30° field of view:
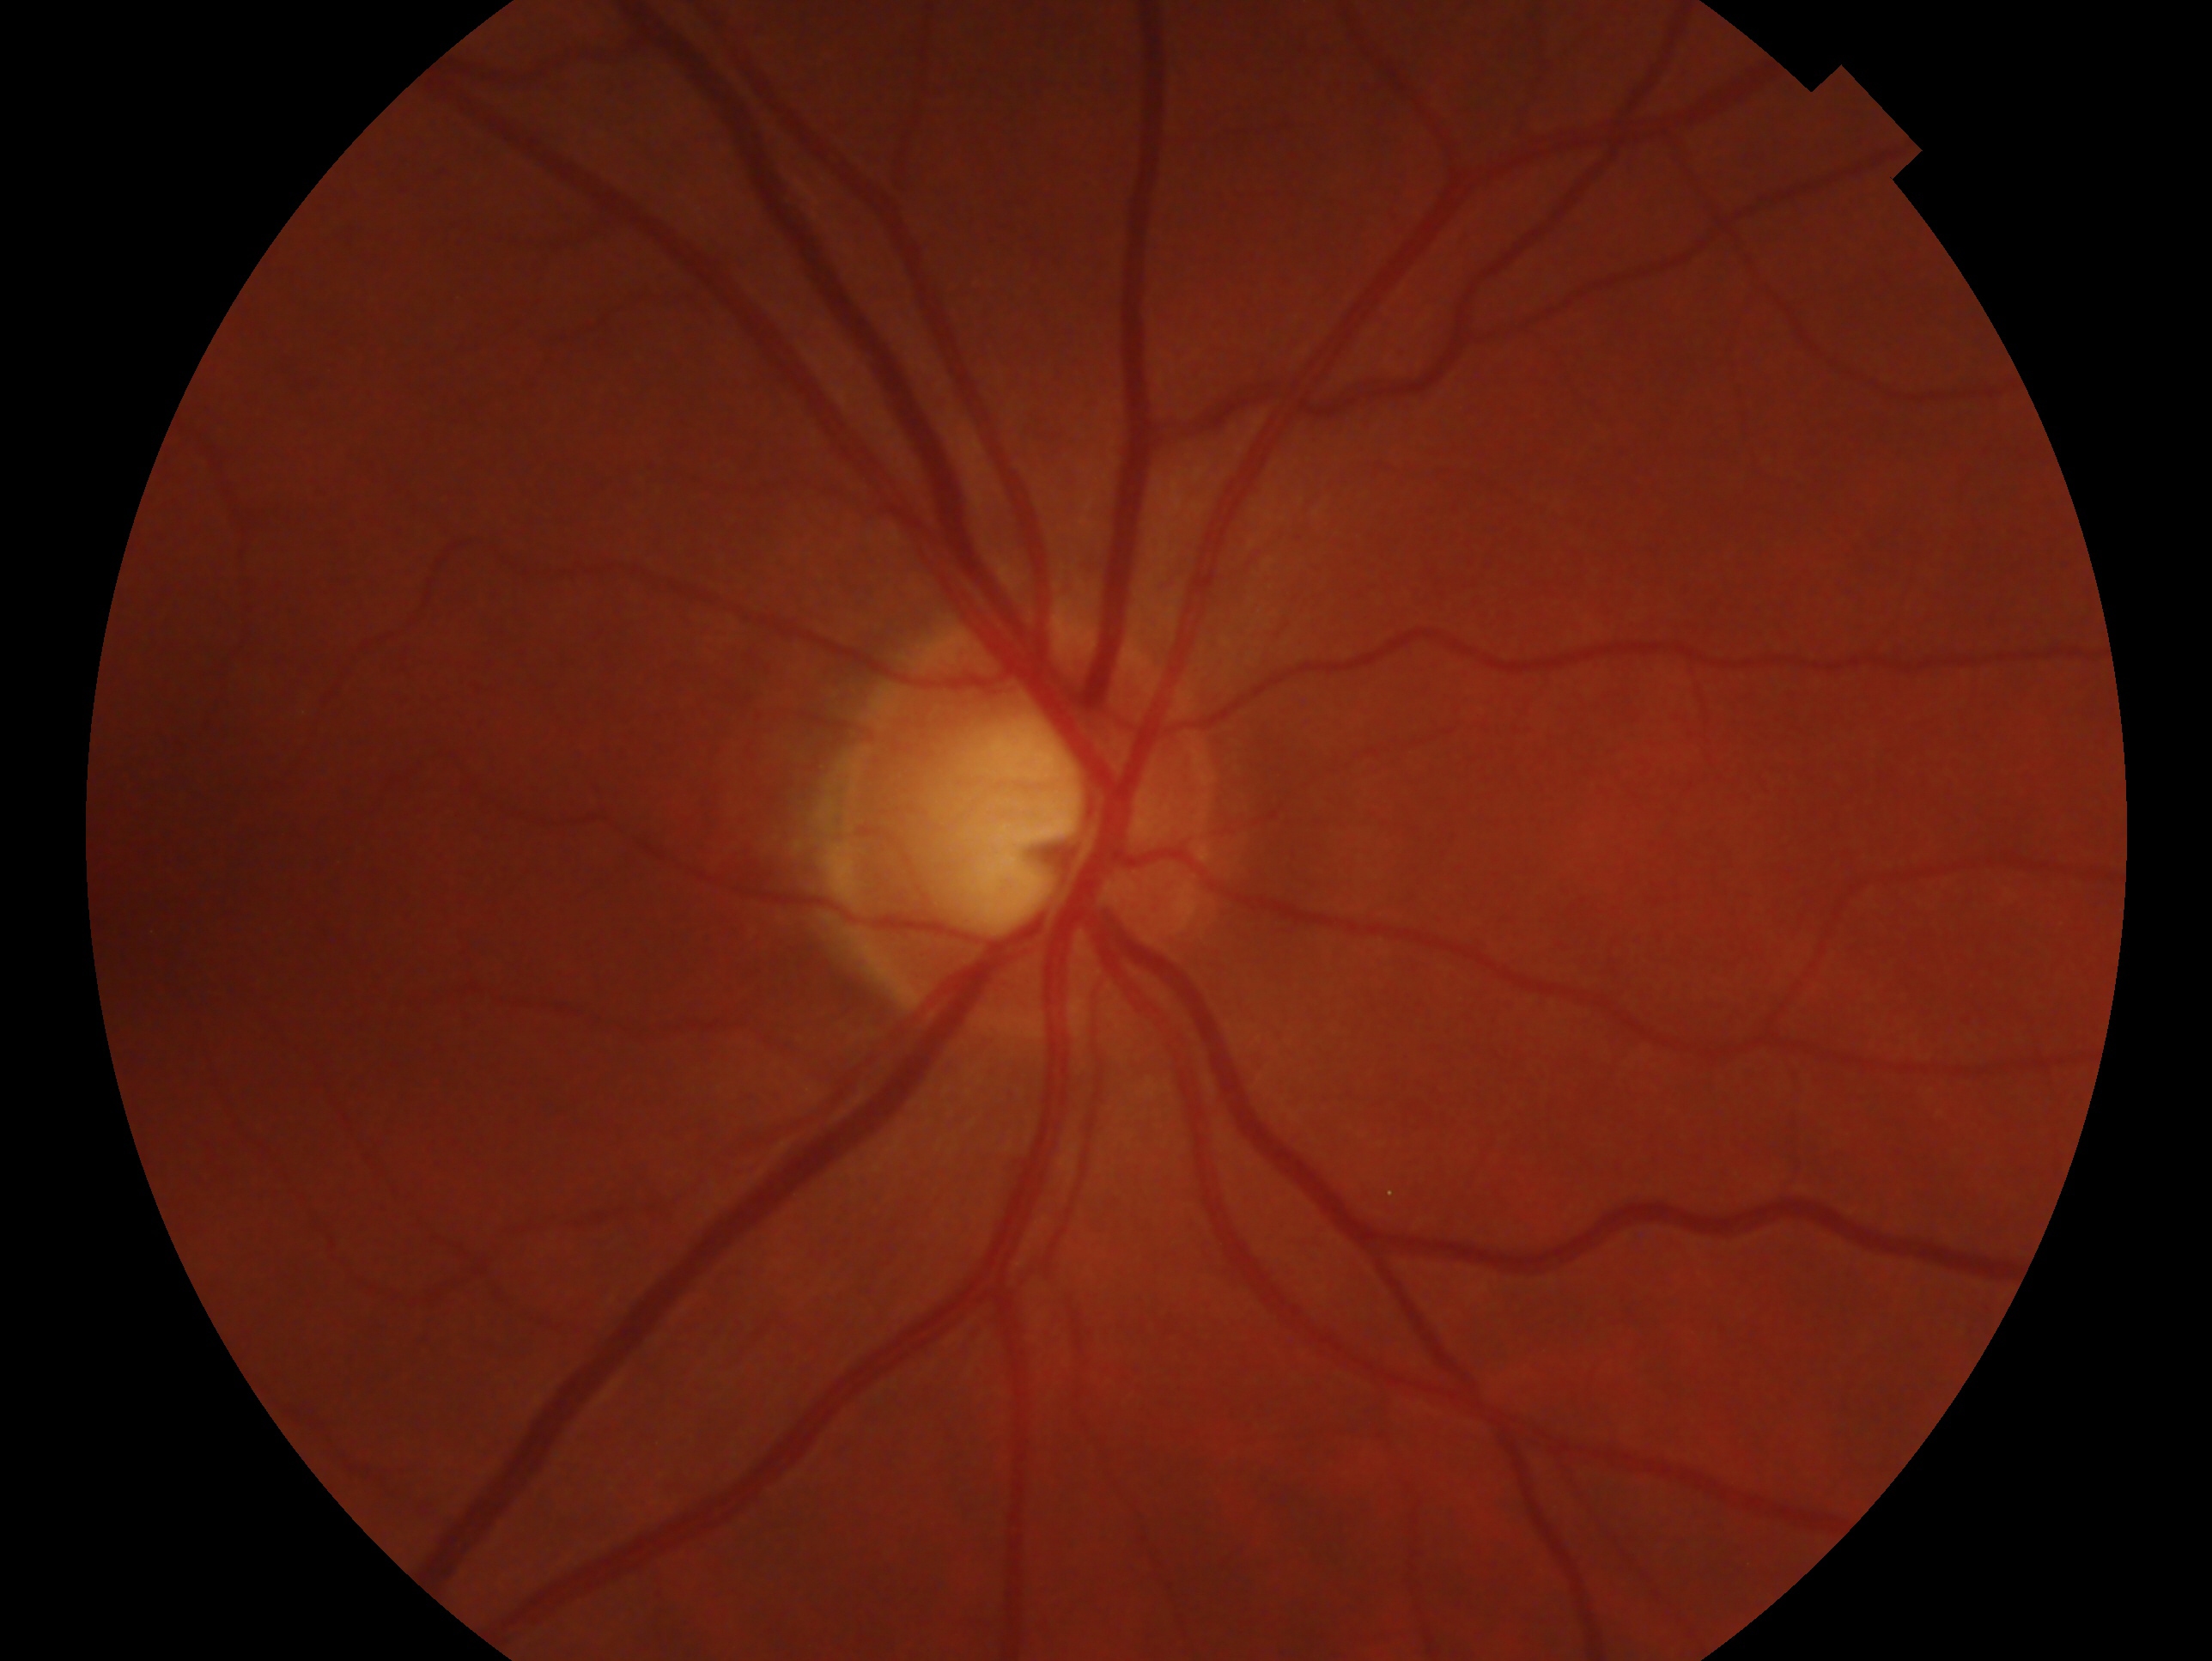
glaucoma diagnosis: cannot be excluded | laterality: right eye.